Image size 1659x2212; camera: Remidio smartphone fundus camera; fundus photo:
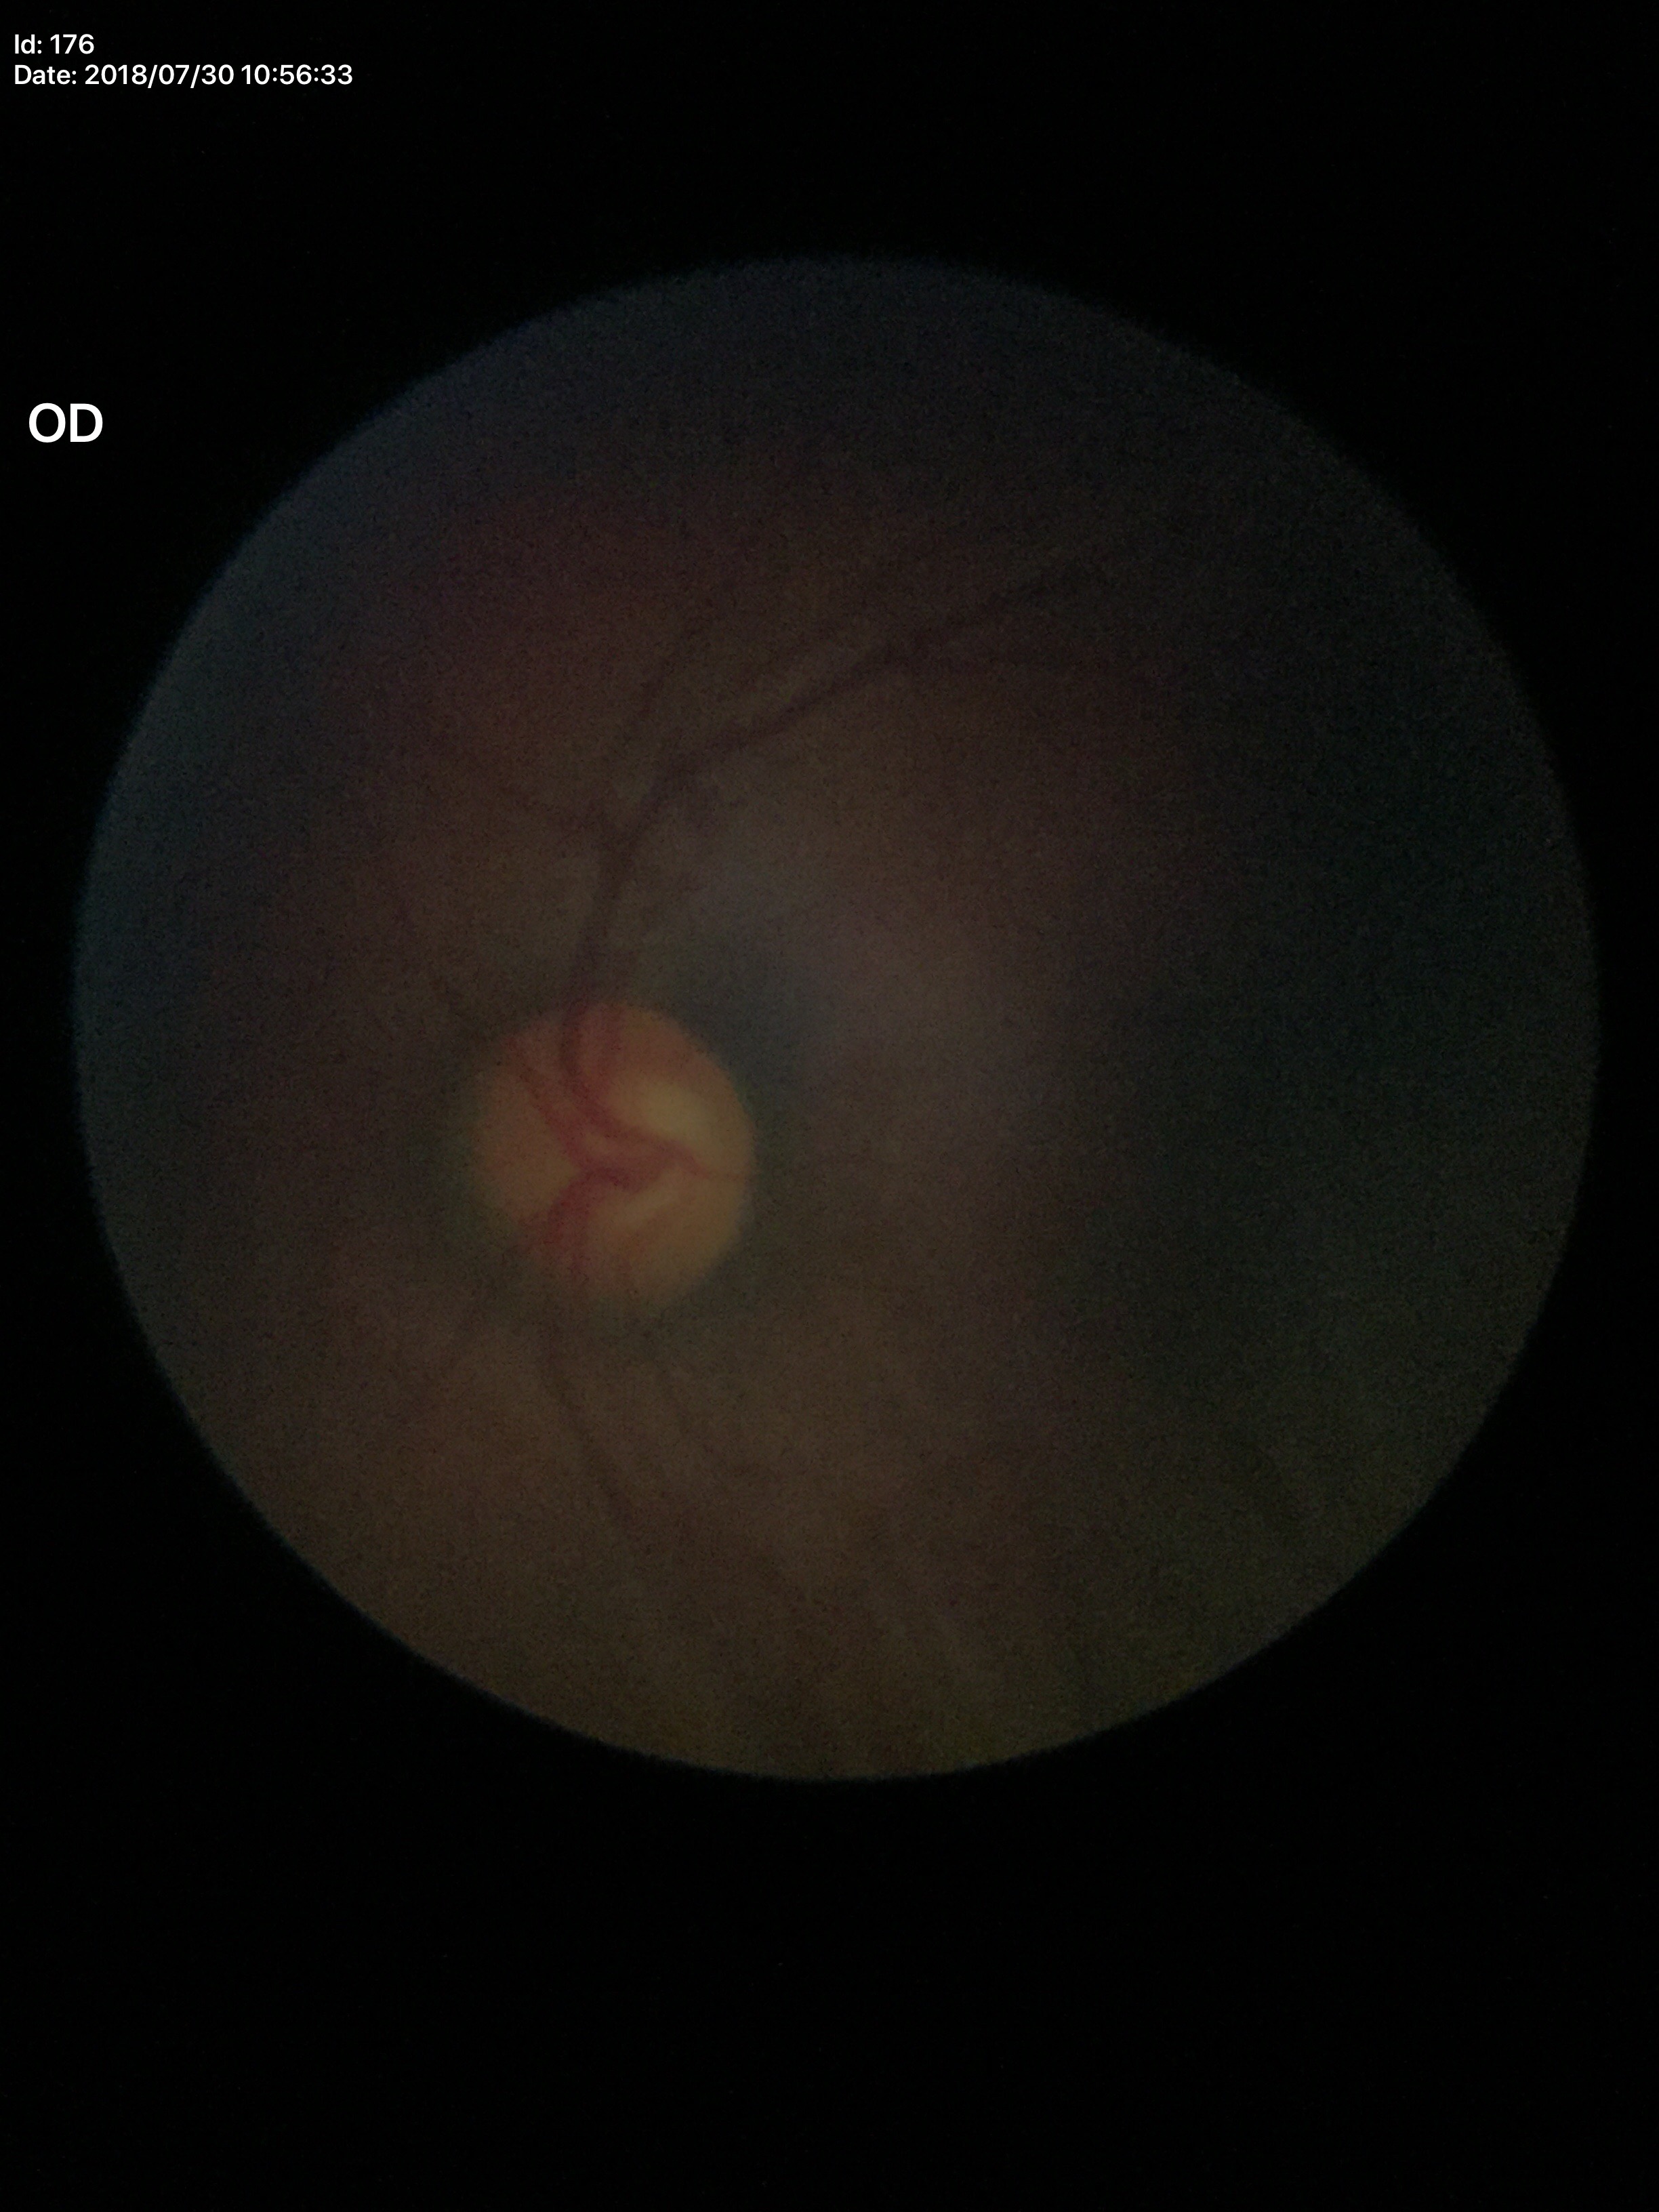
Glaucoma evaluation: not suspect.
Horizontal cup-to-disc ratio (HCDR) of 0.62.
Vertical CDR (VCDR): 0.59.